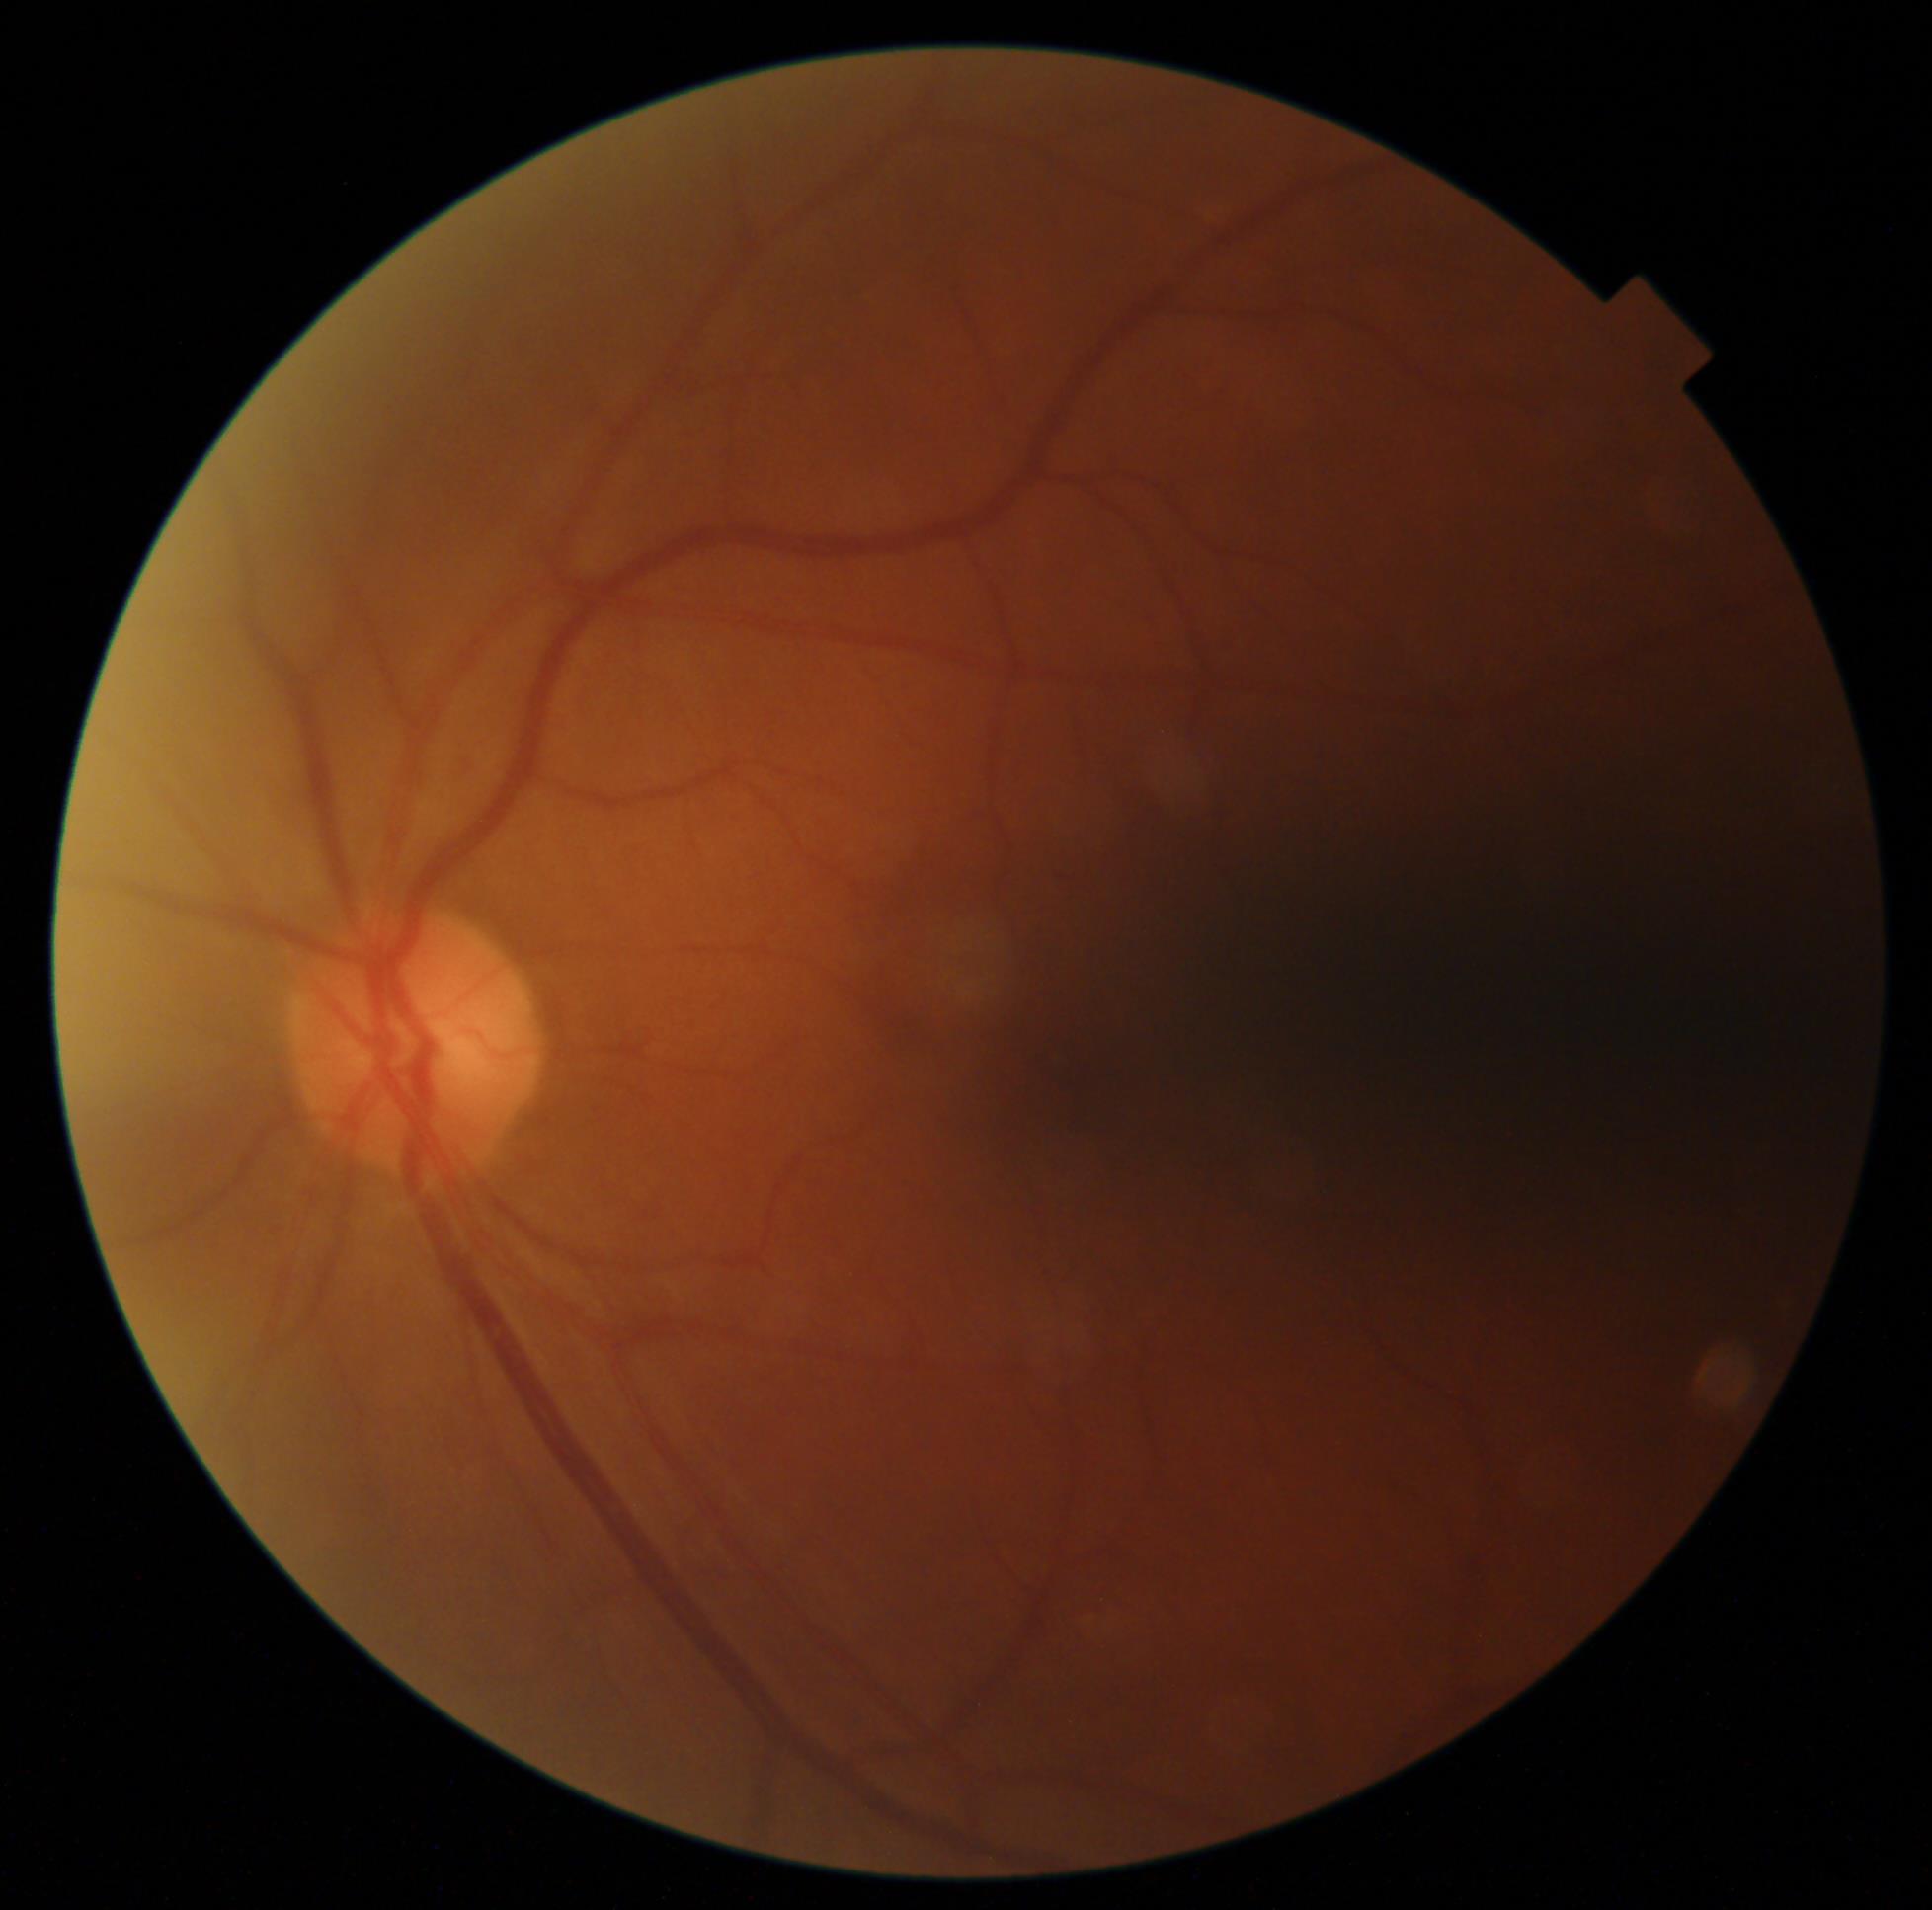 Retinopathy: no apparent diabetic retinopathy (grade 0).